Infant wide-field fundus photograph.
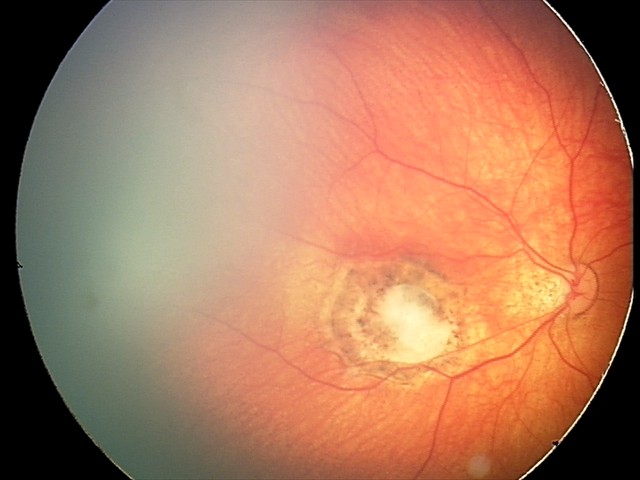 Impression: toxoplasmosis chorioretinitis.